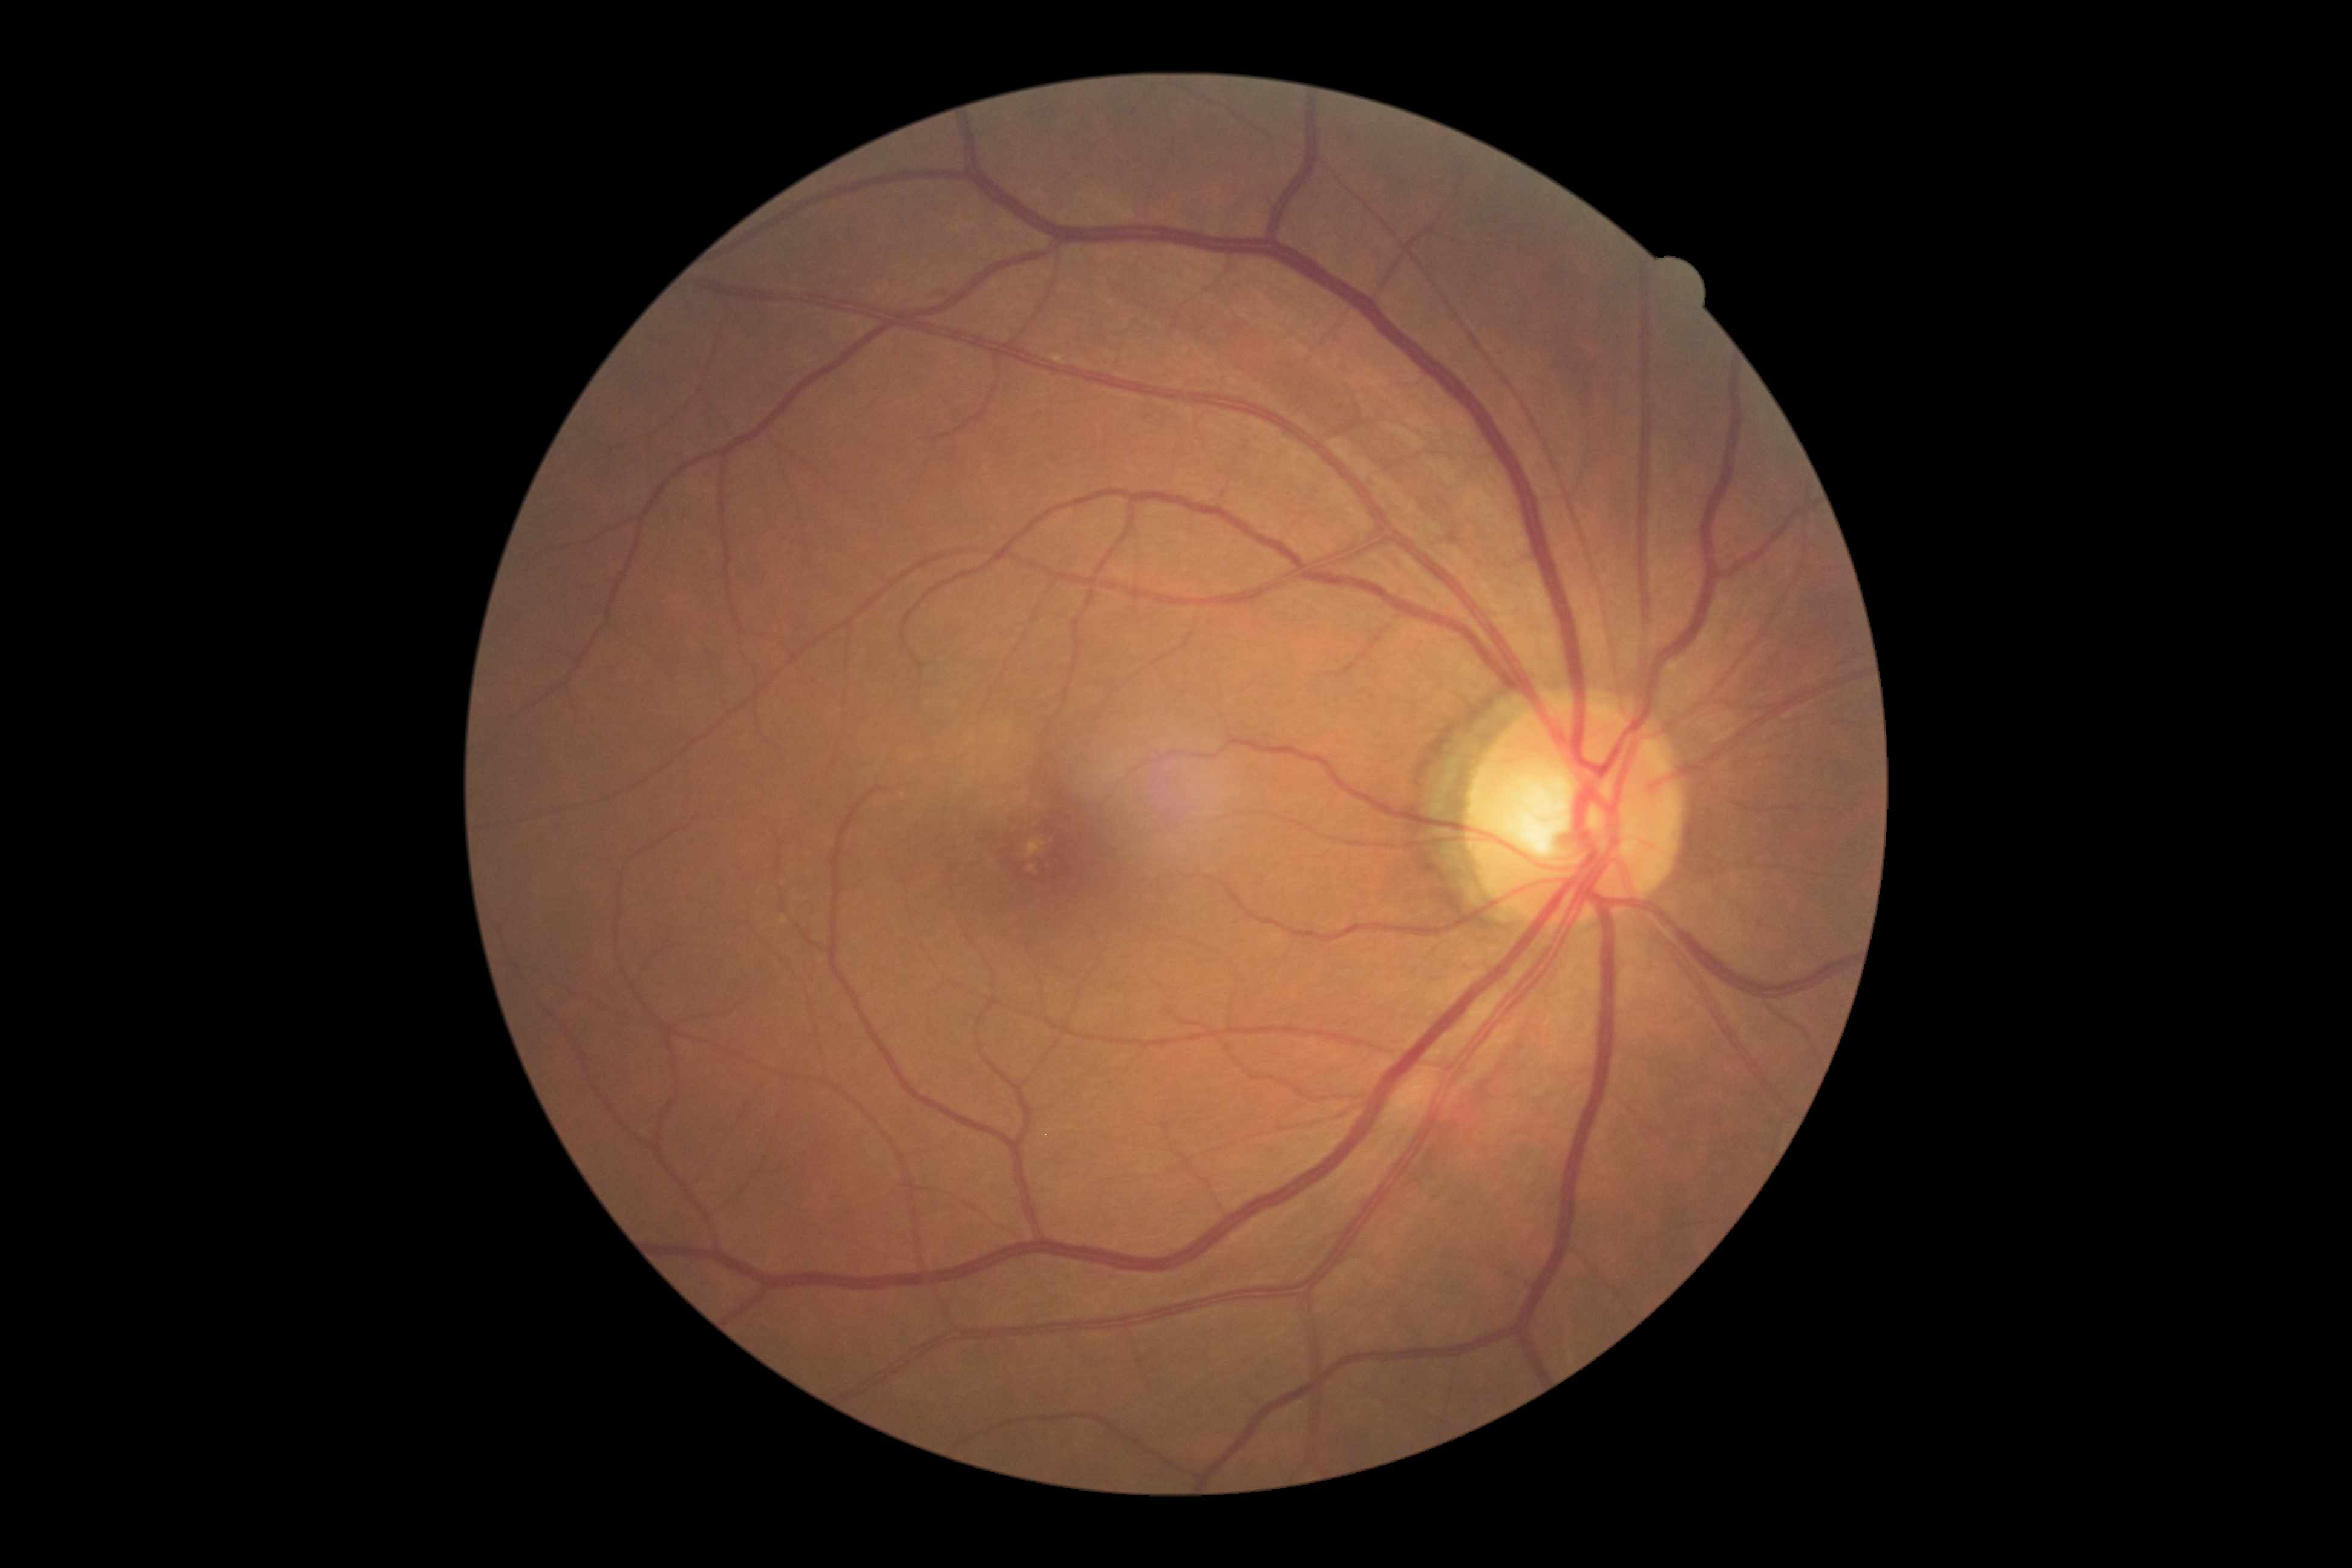
- diabetic retinopathy (DR): grade 0 (no apparent retinopathy)